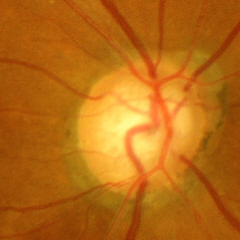 Glaucomatous changes are present. Impression = advanced glaucomatous optic neuropathy.